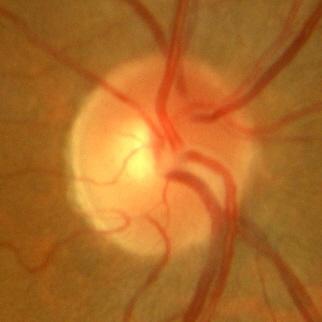 No glaucomatous findings.